Pediatric retinal photograph (wide-field). Captured with the Clarity RetCam 3 (130° field of view) — 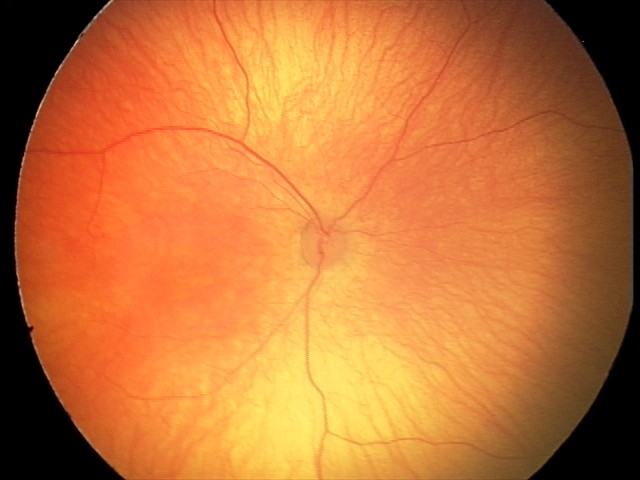

Assessment: normal fundus examination.